2352 by 1568 pixels, 45° FOV:
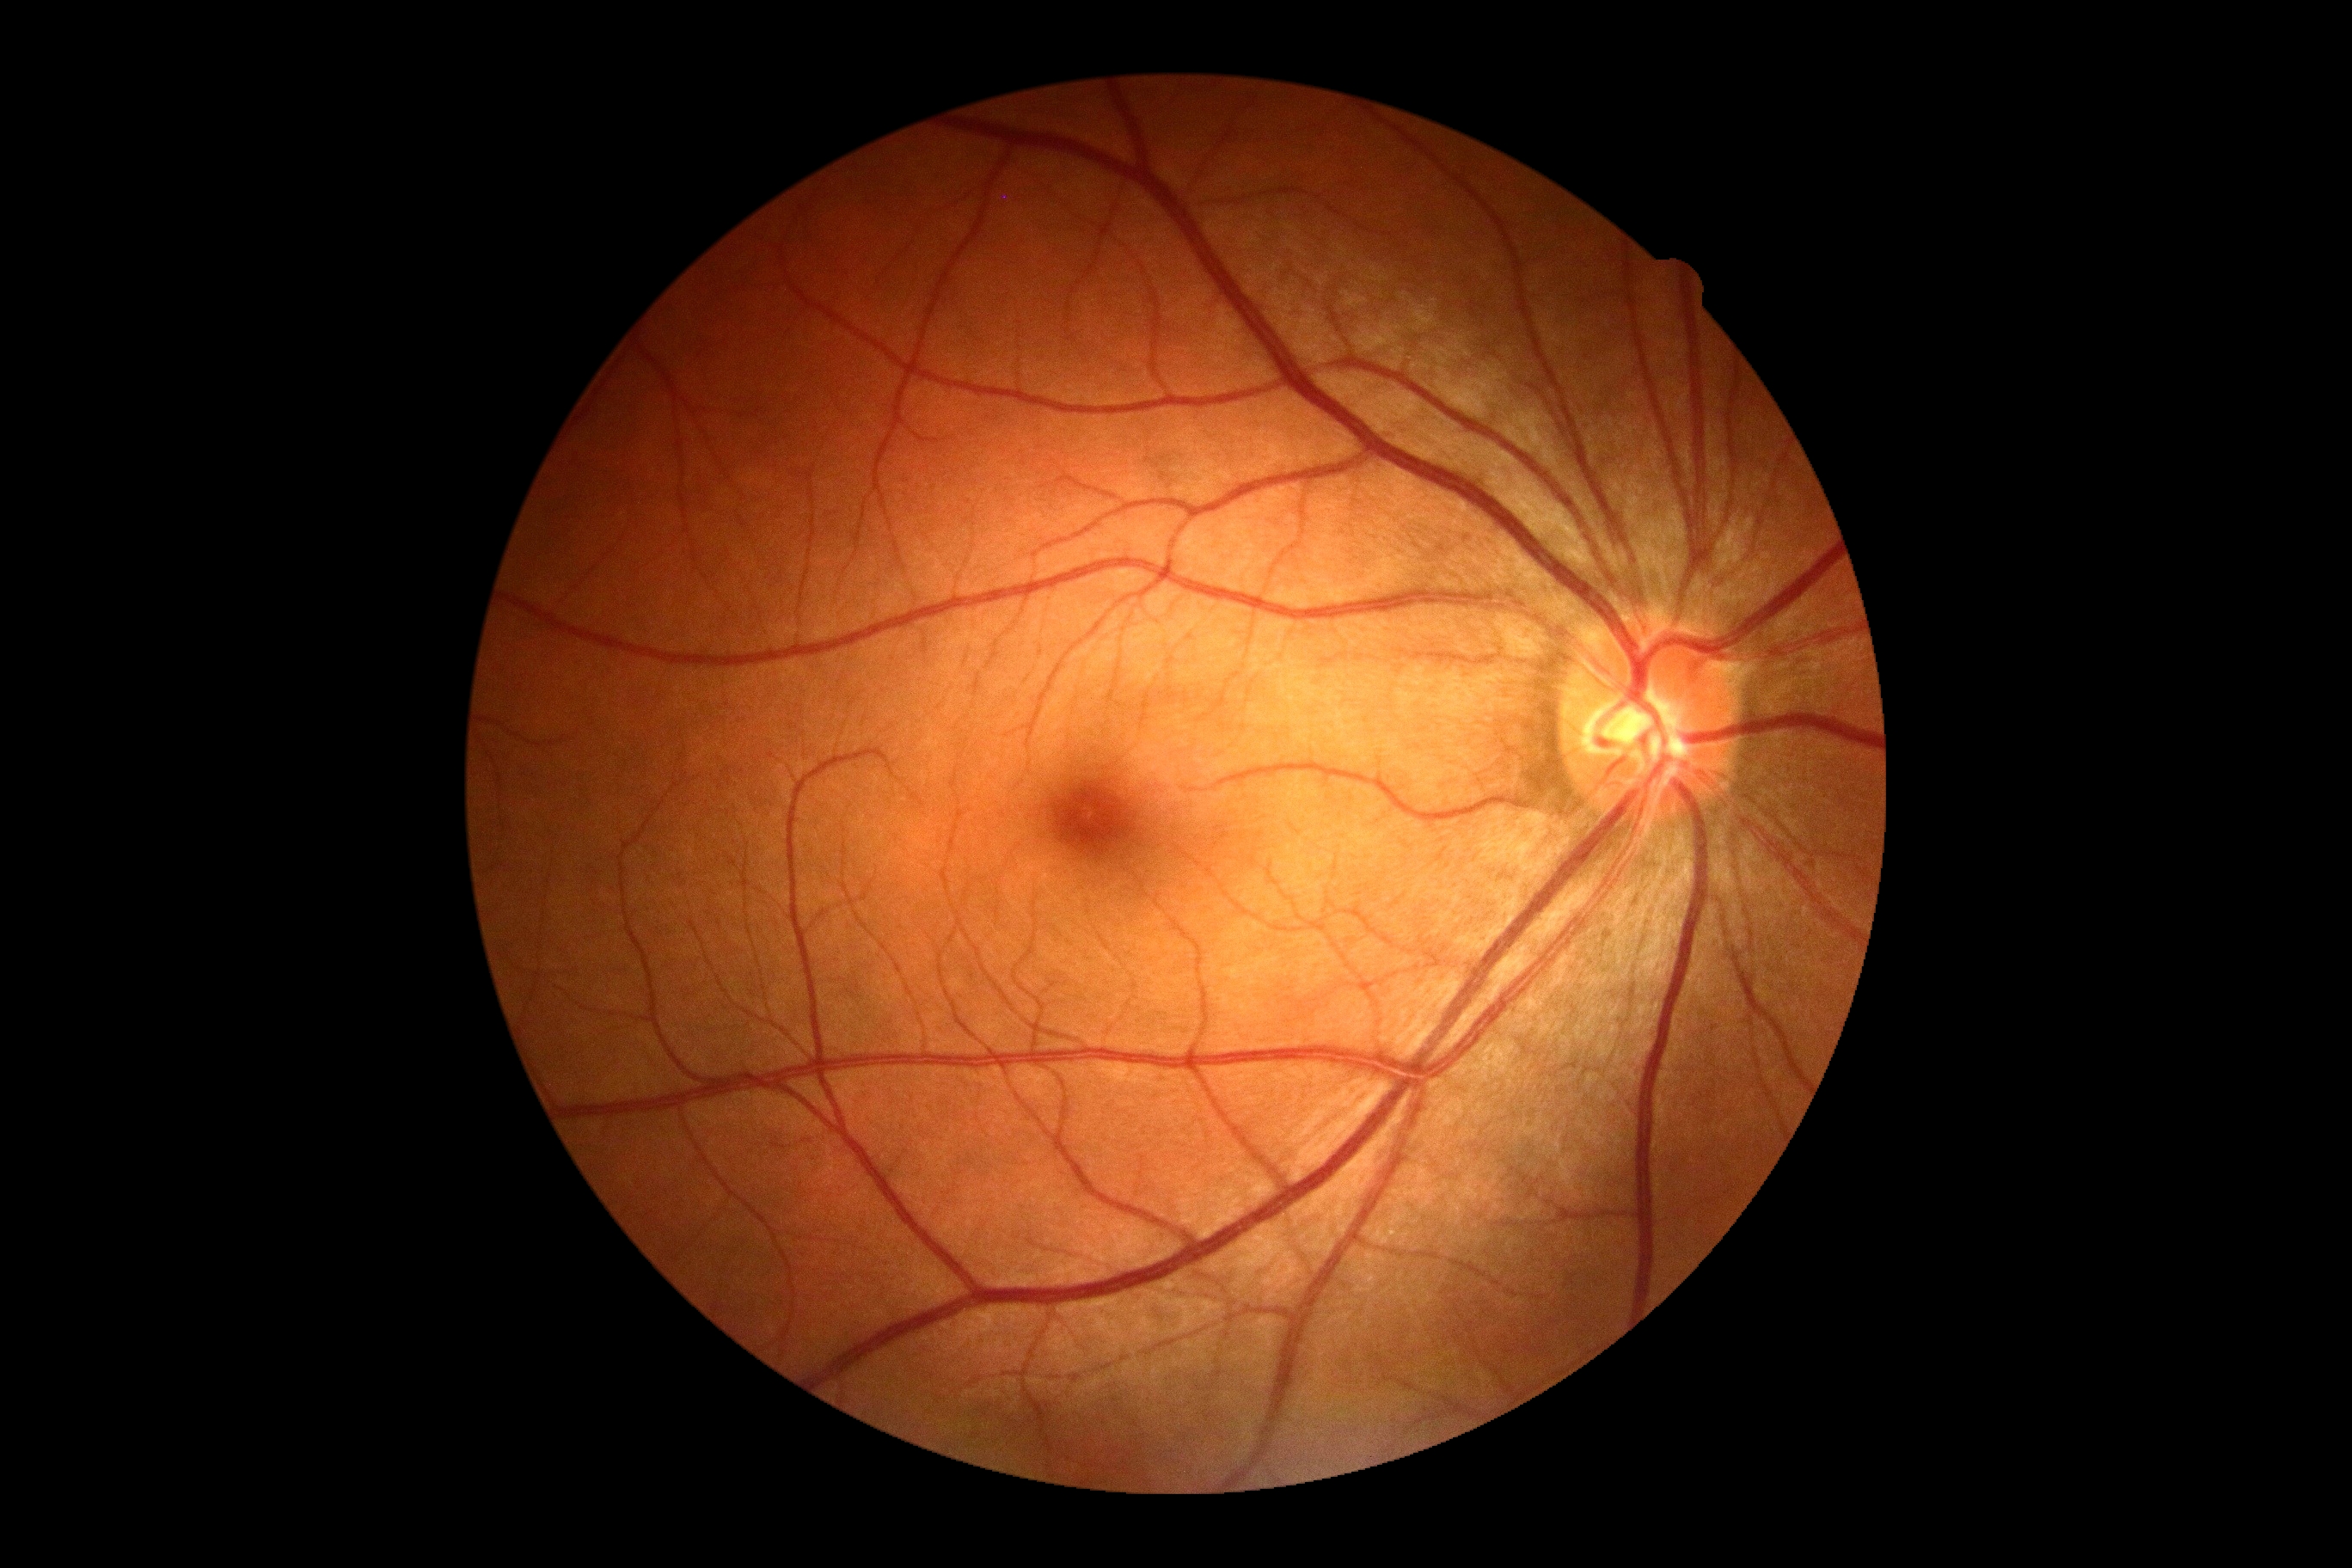

DR severity = grade 0.